Color fundus photograph
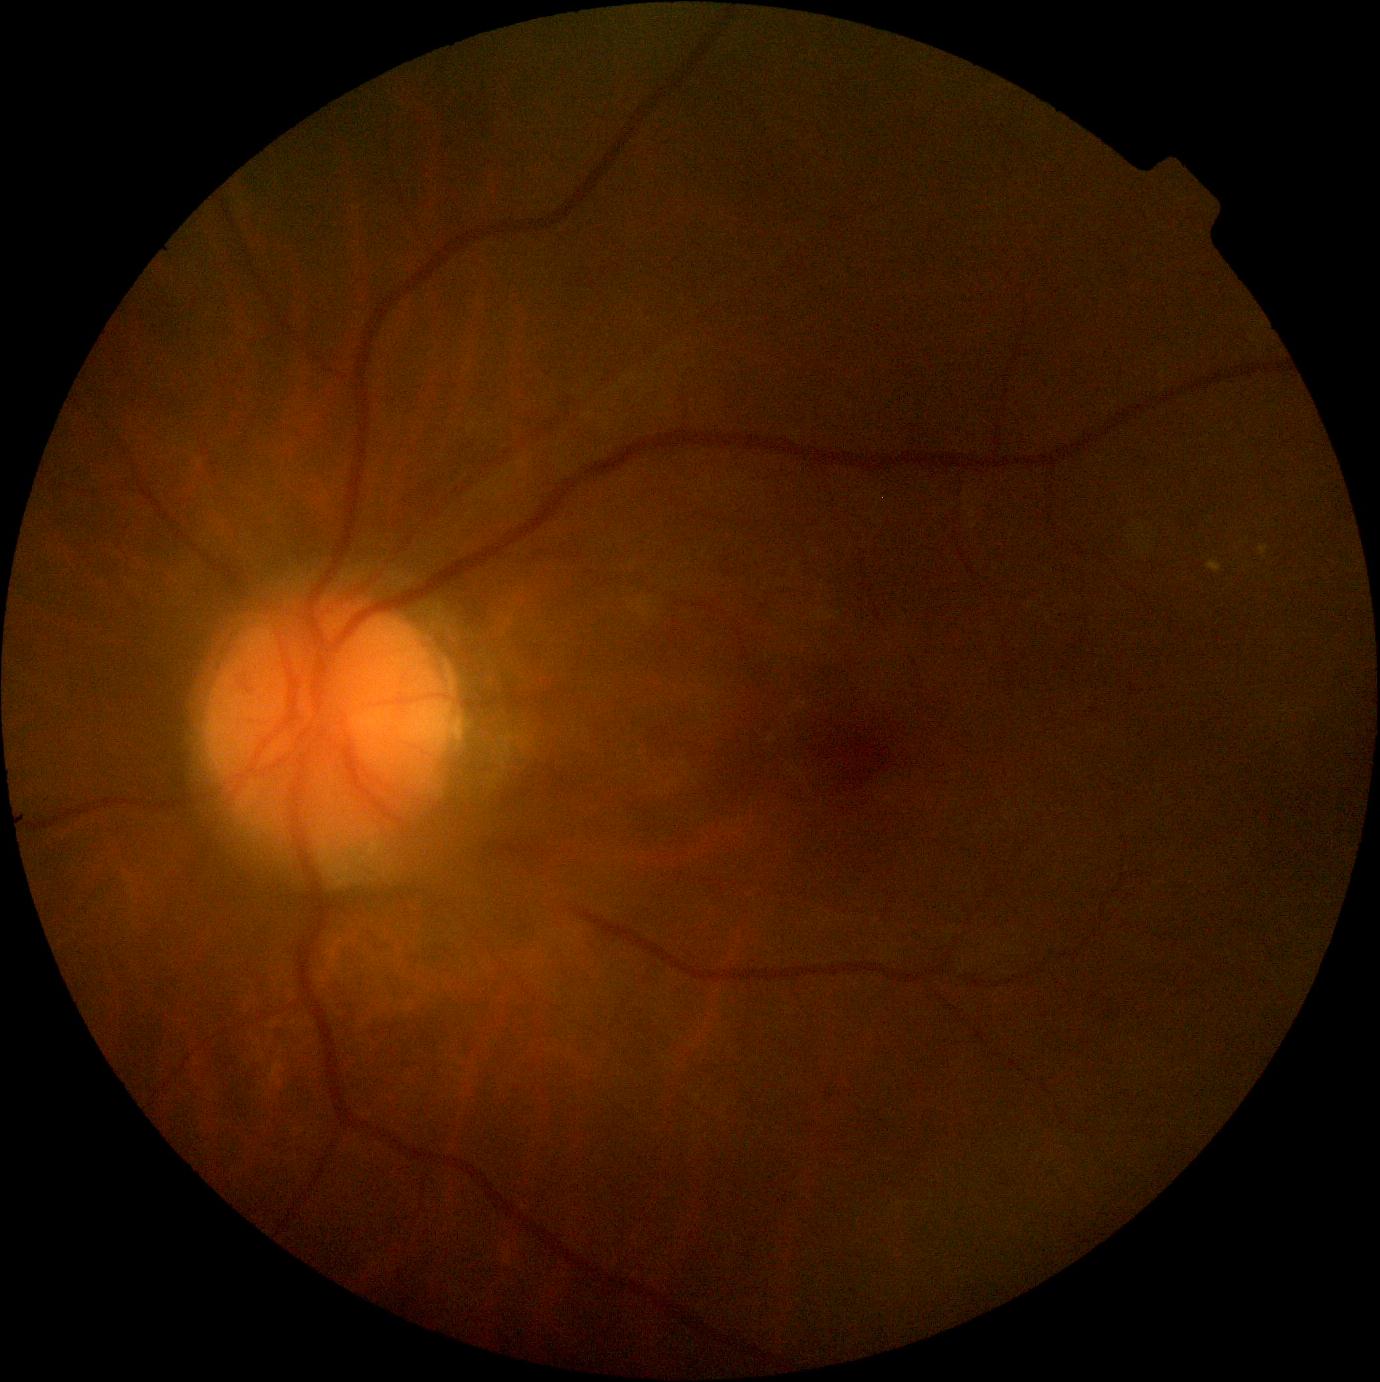
Diabetic retinopathy (DR) is moderate non-proliferative diabetic retinopathy (grade 2).